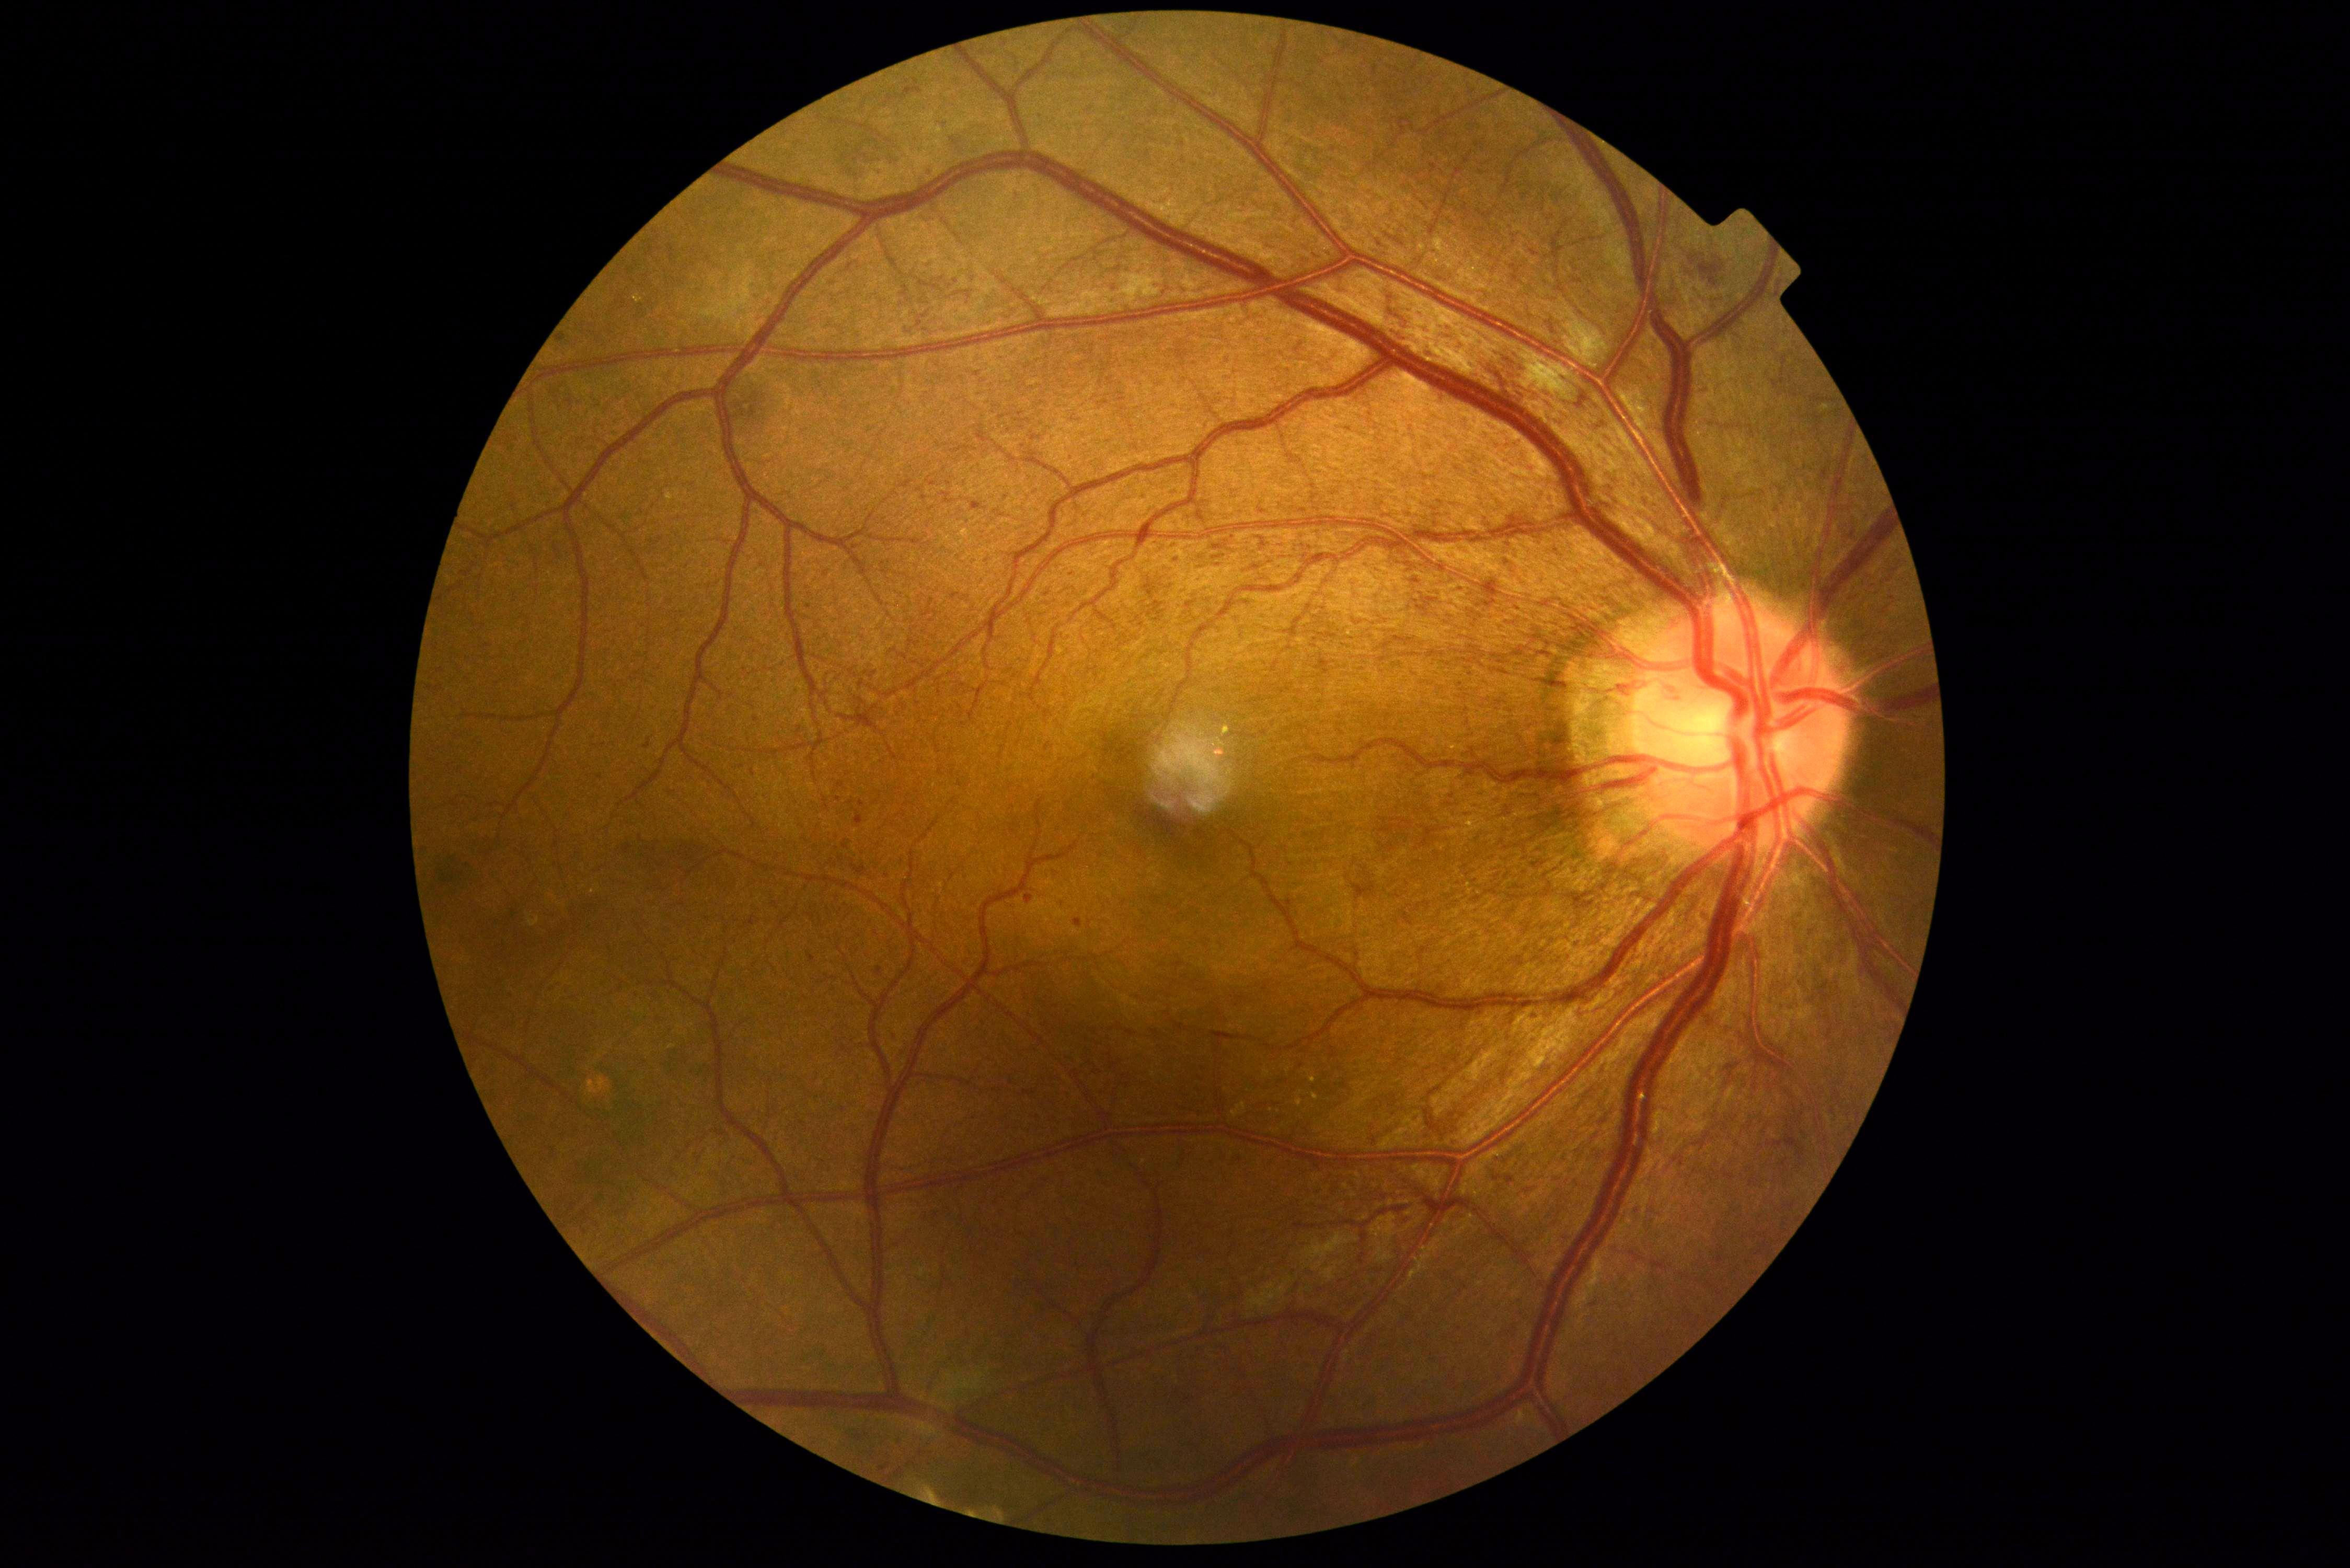
dr_grade: grade 2